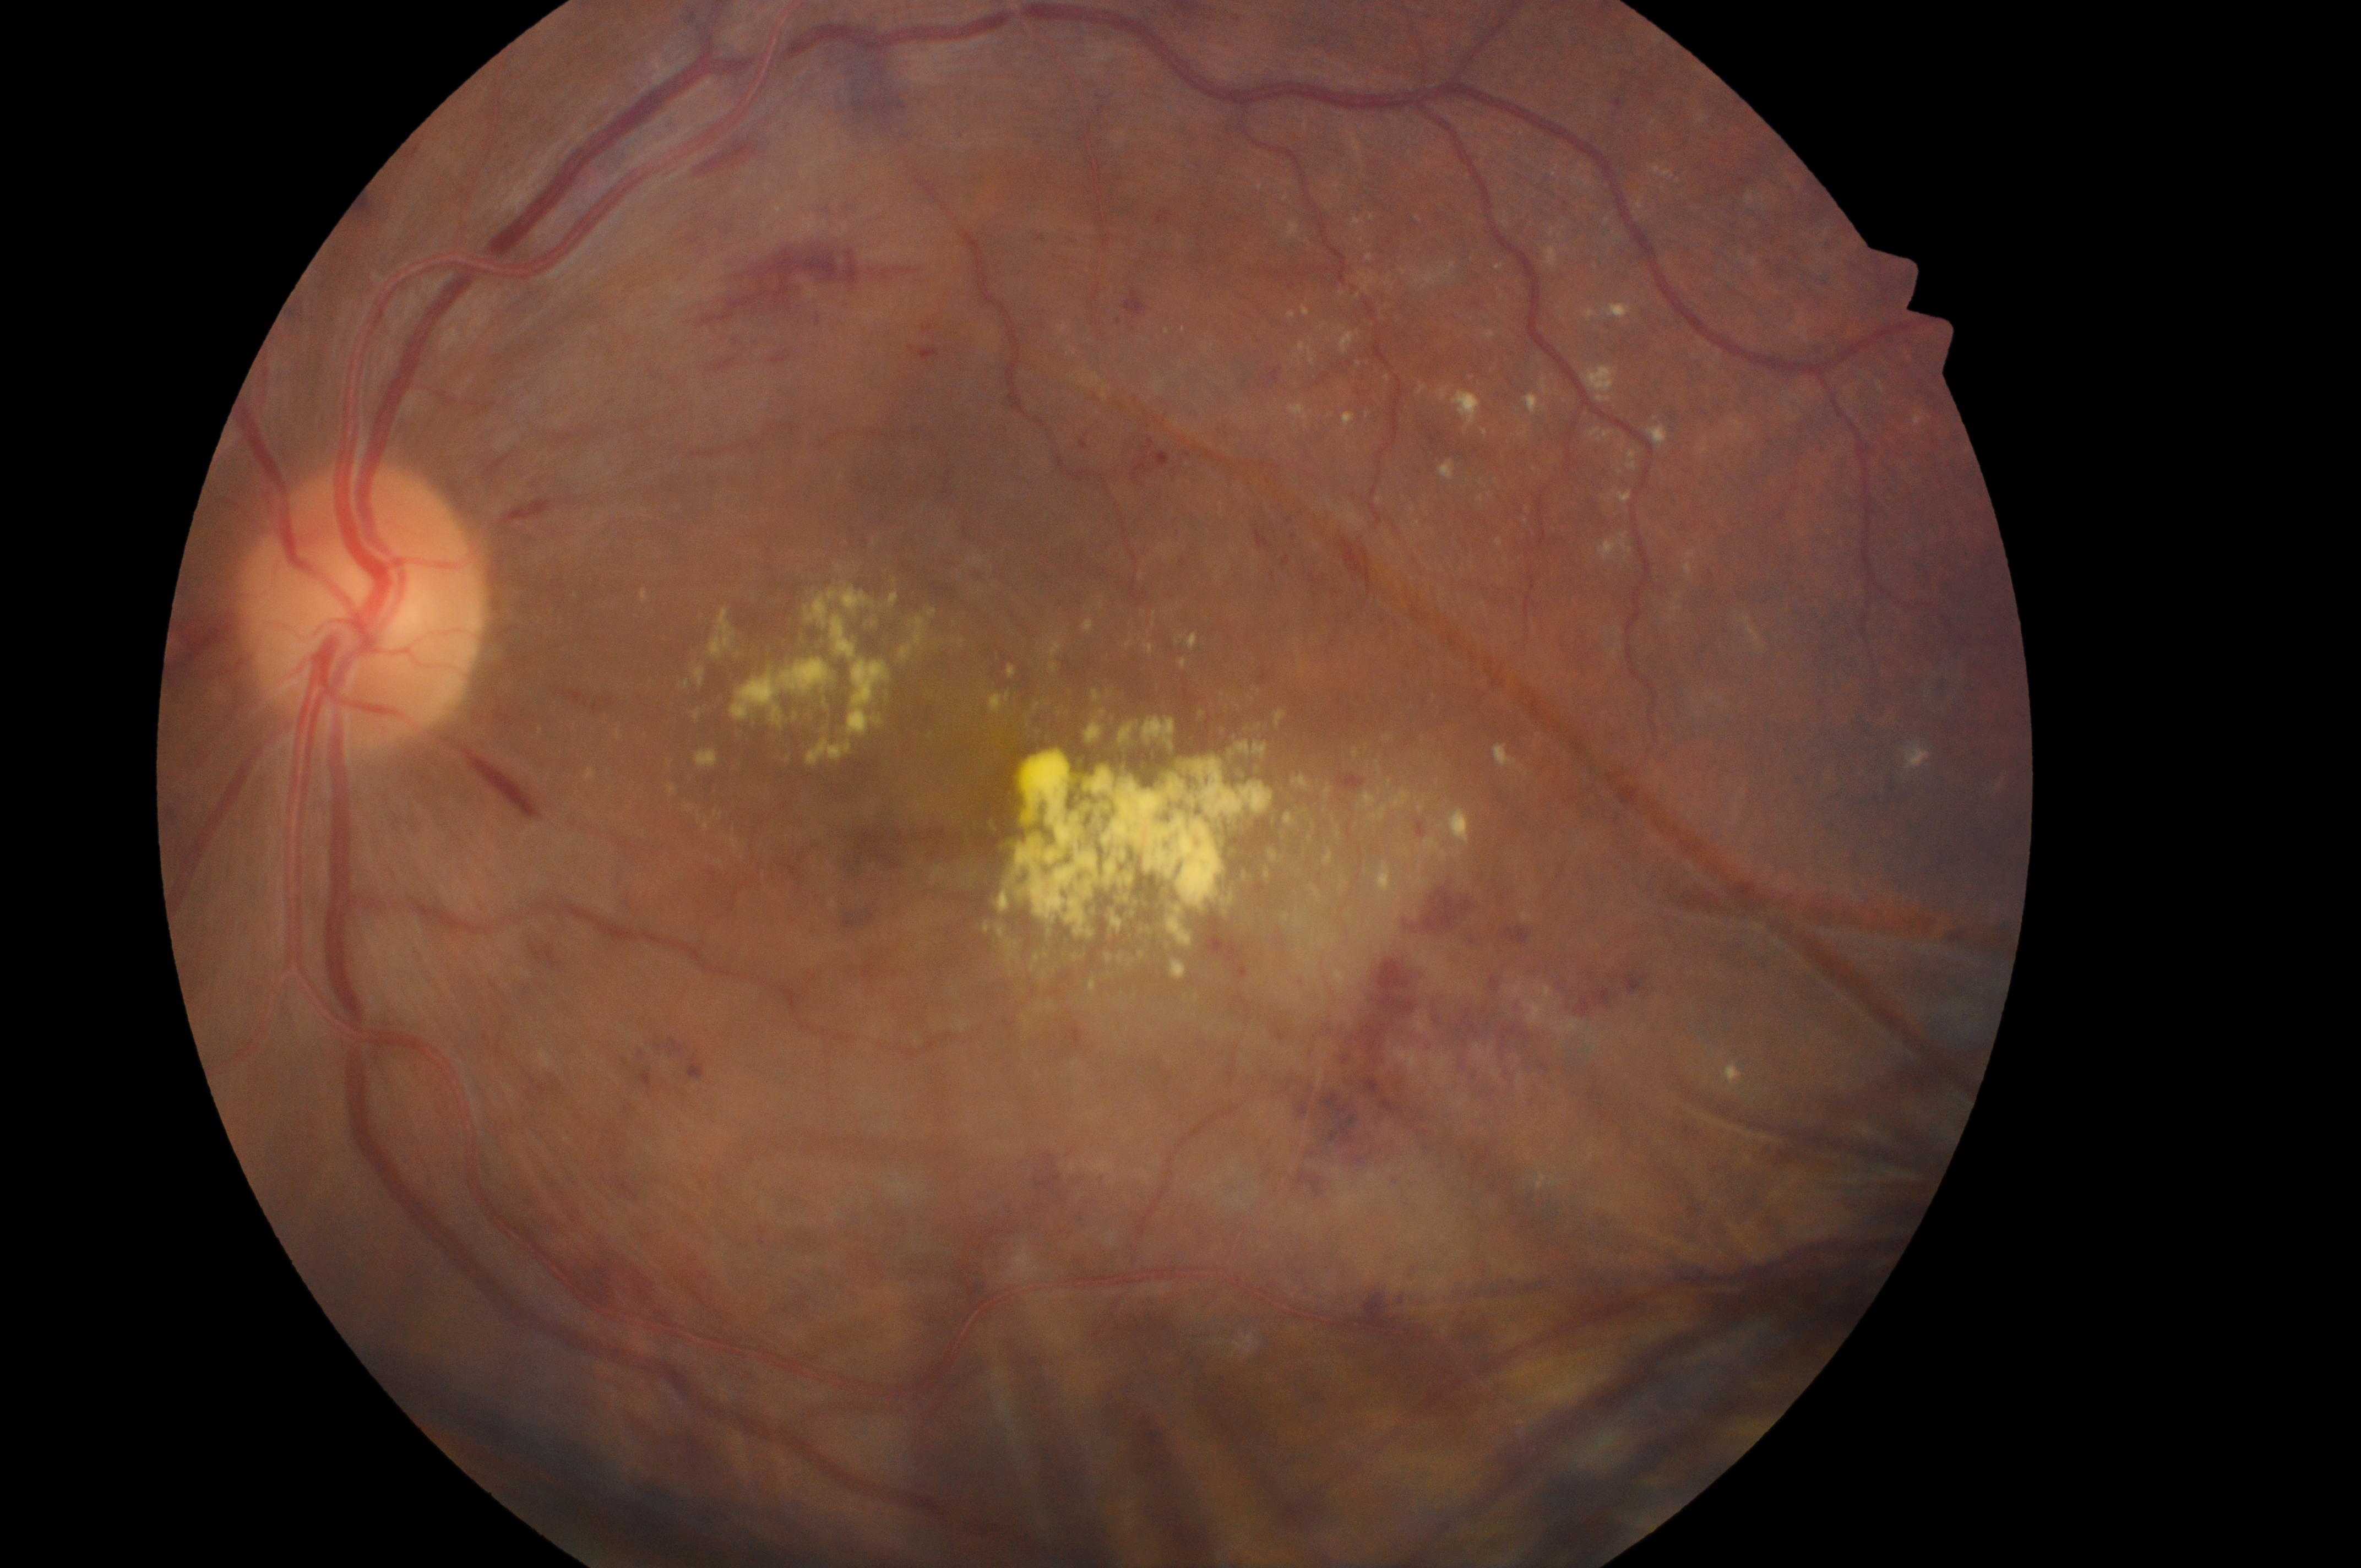 The ONH is at (x: 361, y: 616). Eye: left. DR stage: grade 3 (severe NPDR). DME is grade 2 (high risk). Macular center located at (x: 1048, y: 694).